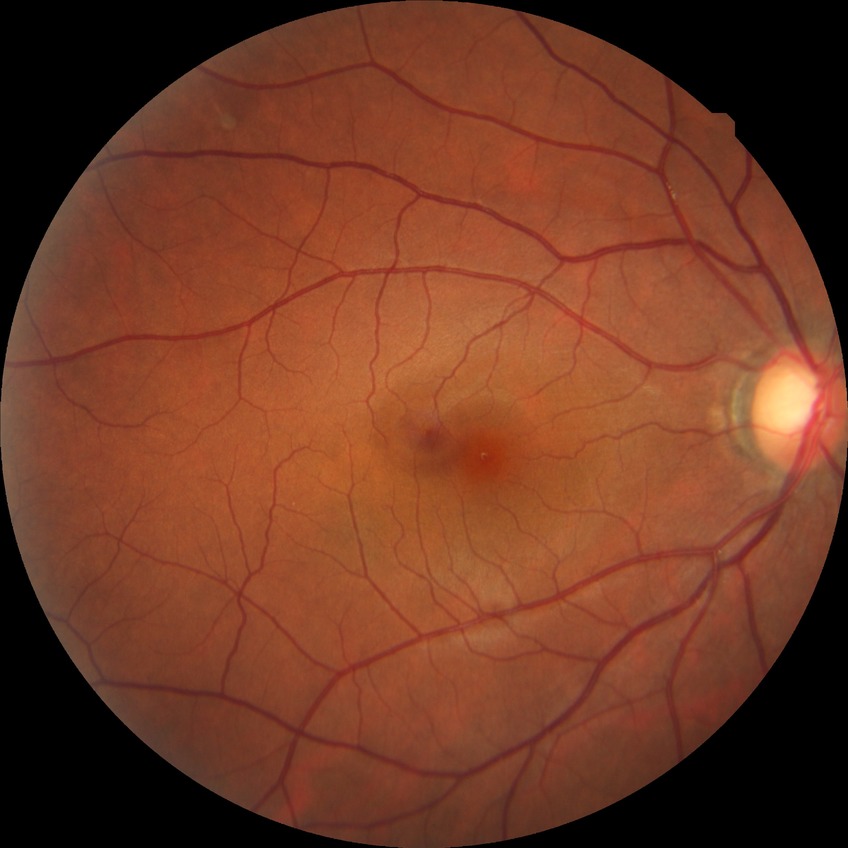
Findings:
• diabetic retinopathy (DR): NDR (no diabetic retinopathy)